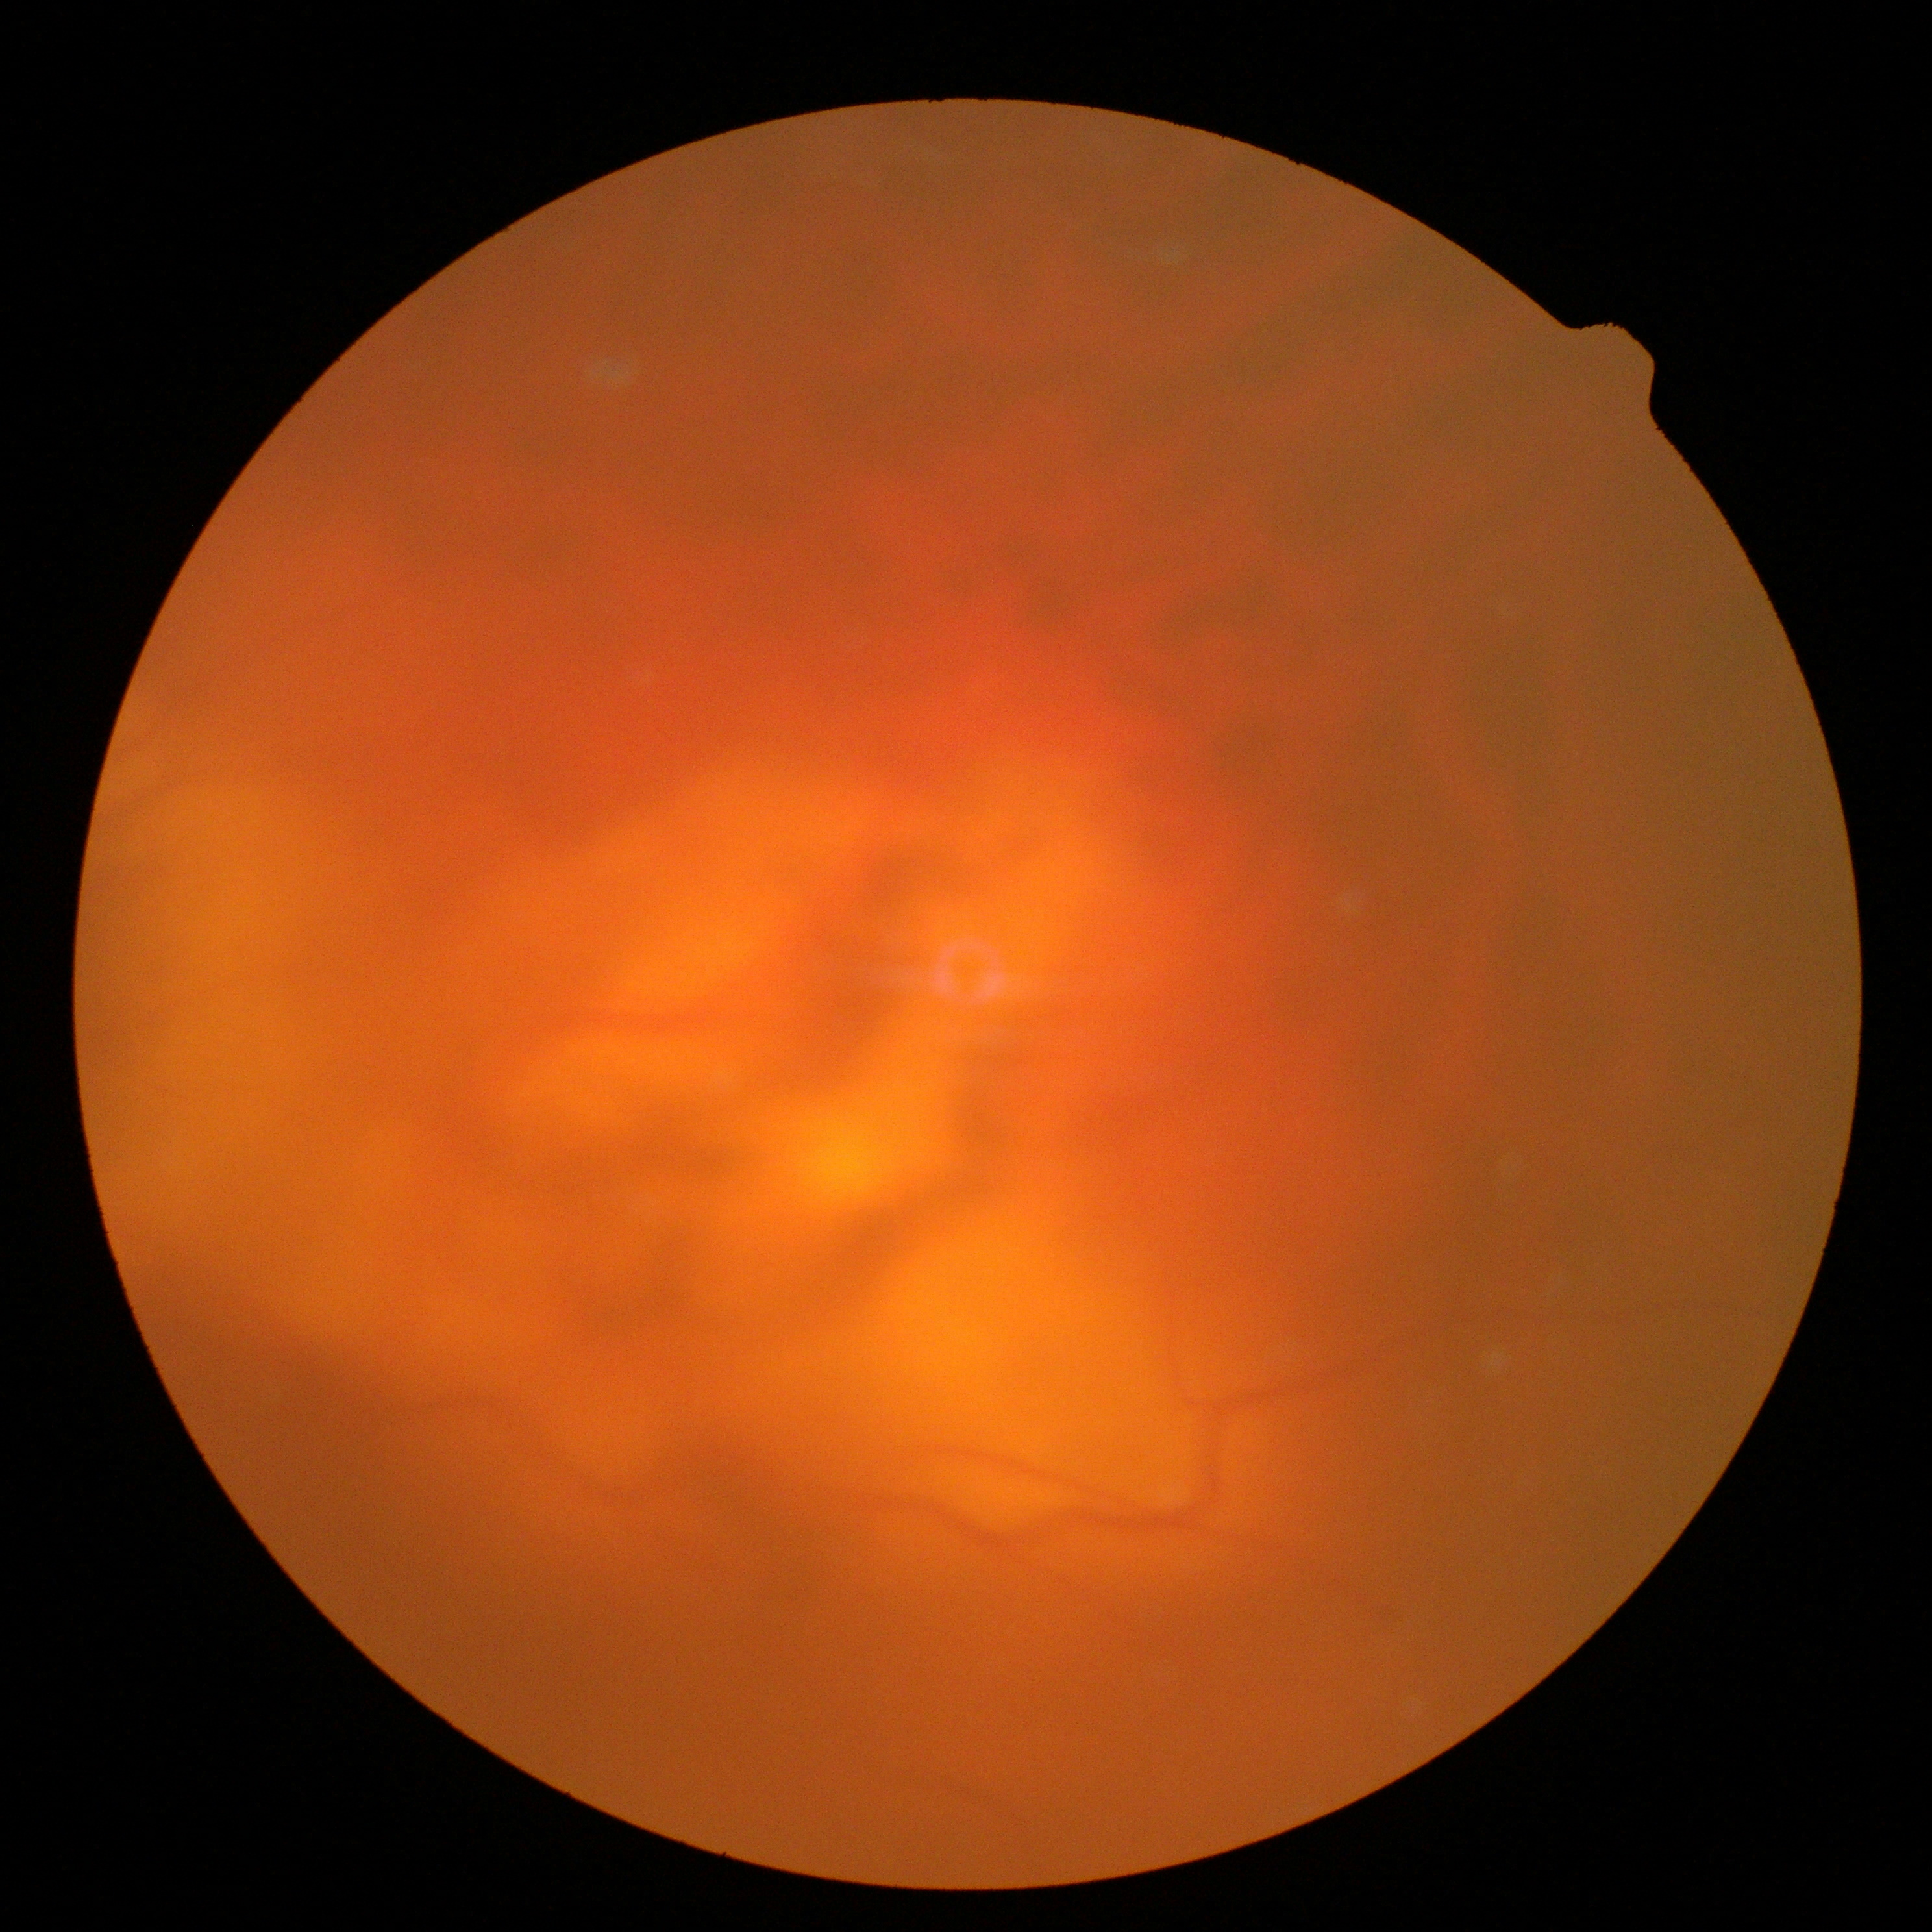

The image cannot be graded for diabetic retinopathy. DR is ungradable due to poor image quality.